848x848px: 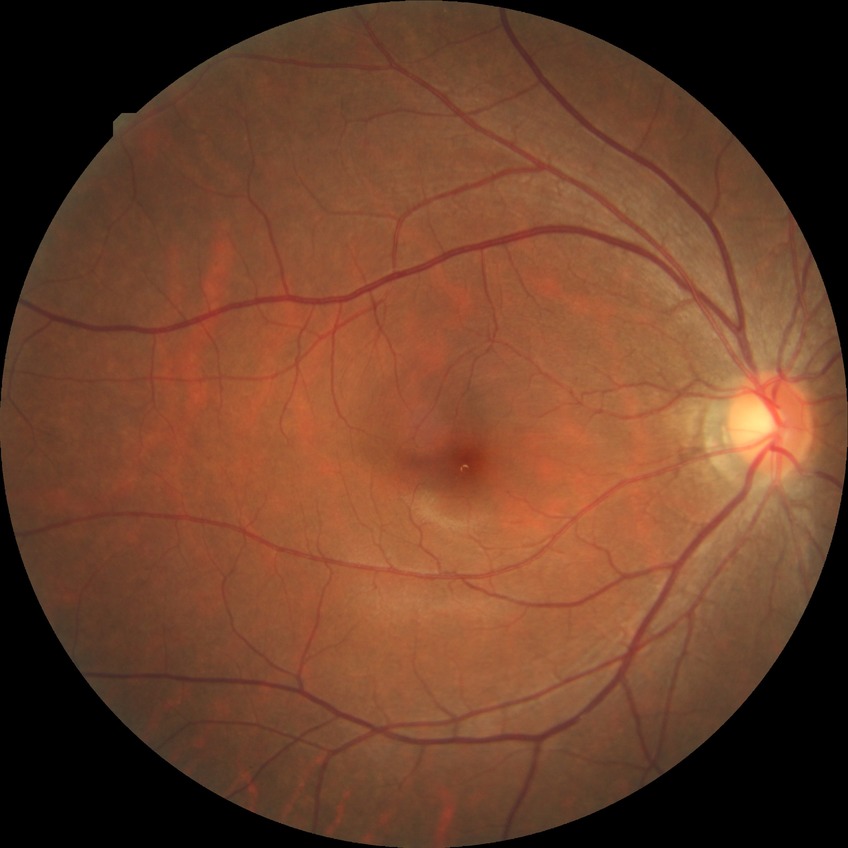 Modified Davis grading: no diabetic retinopathy.